Diabetic retinopathy graded by the modified Davis classification:
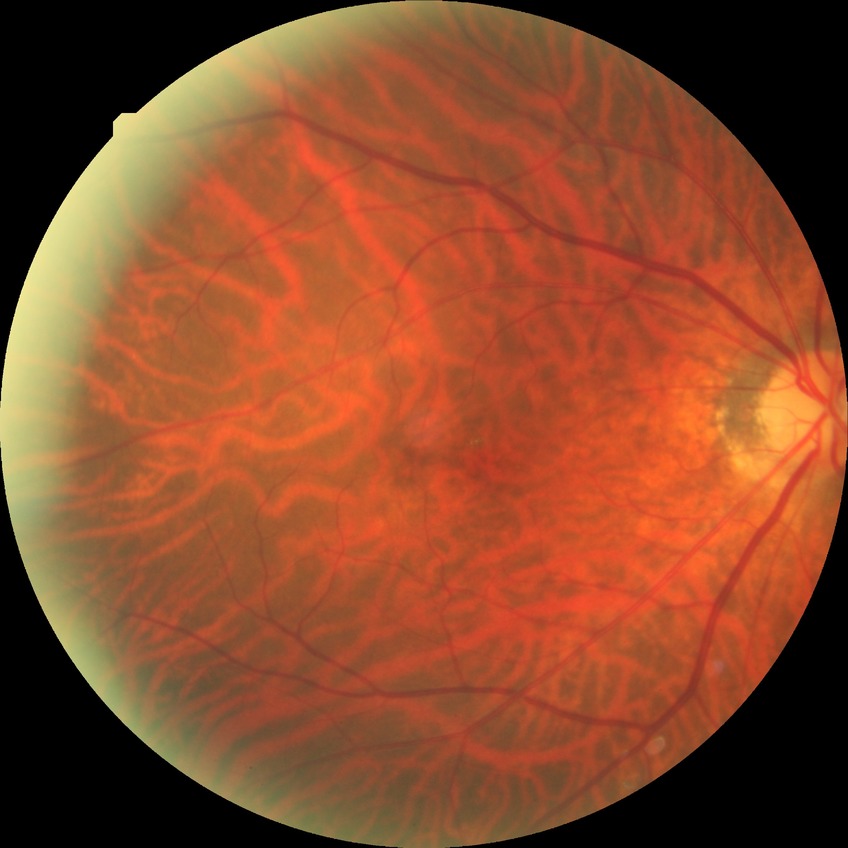
DR stage: NDR.